Camera: NIDEK AFC-230. Diabetic retinopathy graded by the modified Davis classification.
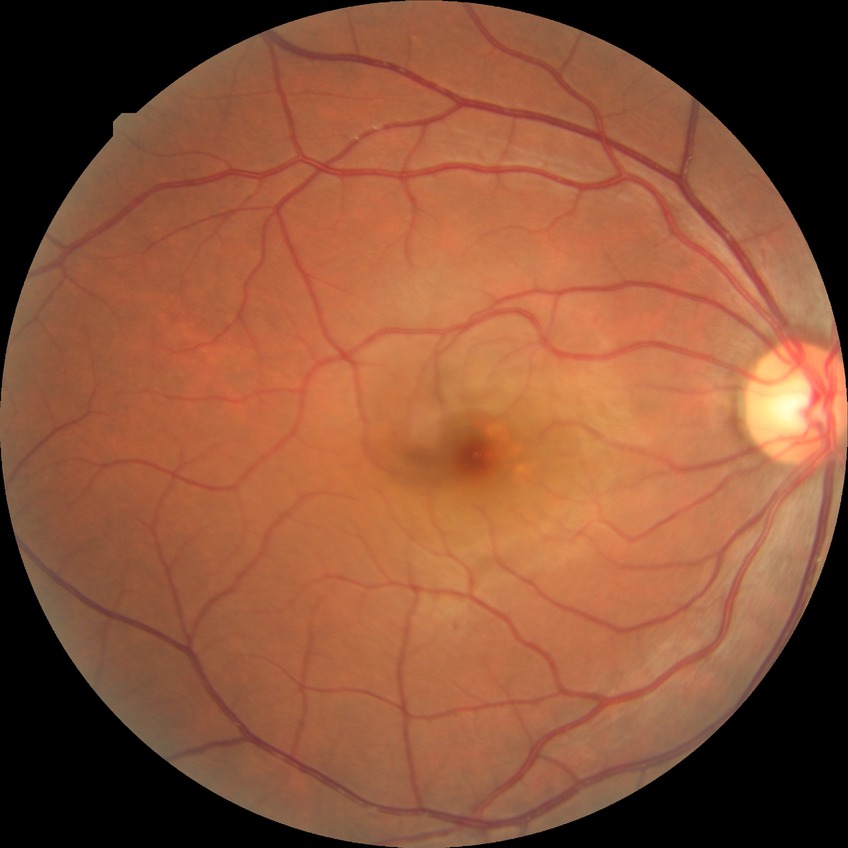
Diabetic retinopathy (DR): SDR (simple diabetic retinopathy).